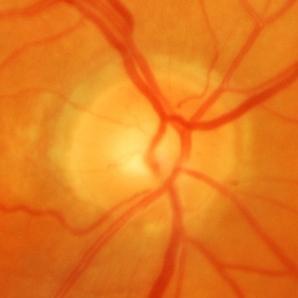 Q: Is glaucoma present?
A: Glaucoma.